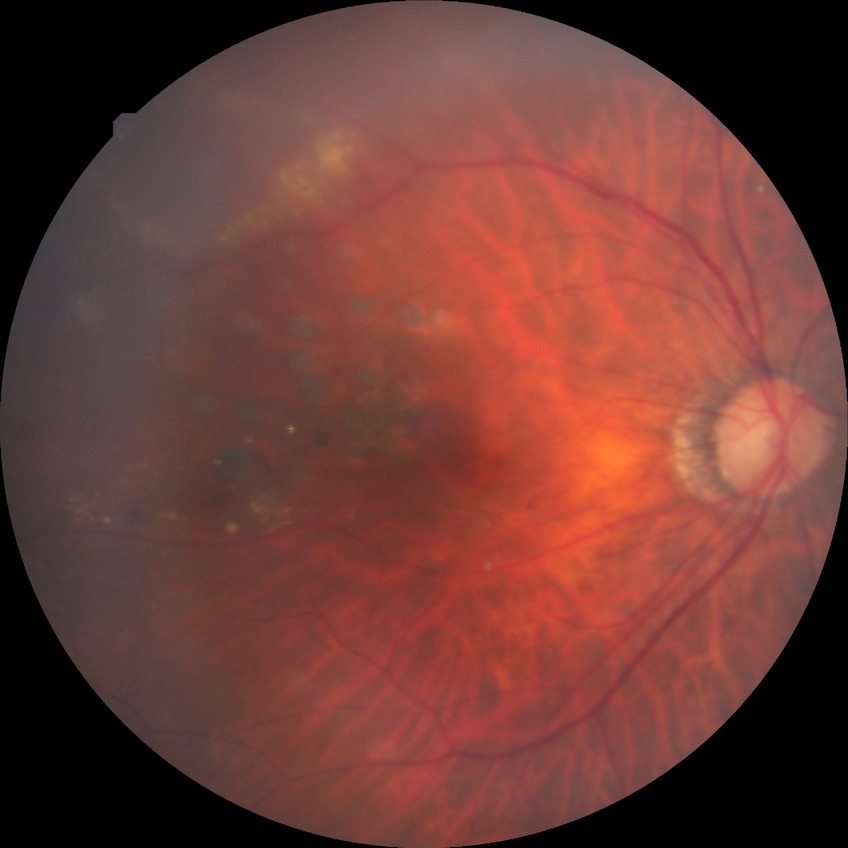 Diabetic retinopathy (DR) is proliferative diabetic retinopathy (PDR).